1240 by 1240 pixels; wide-field fundus photograph from neonatal ROP screening; camera: Phoenix ICON (100° FOV).
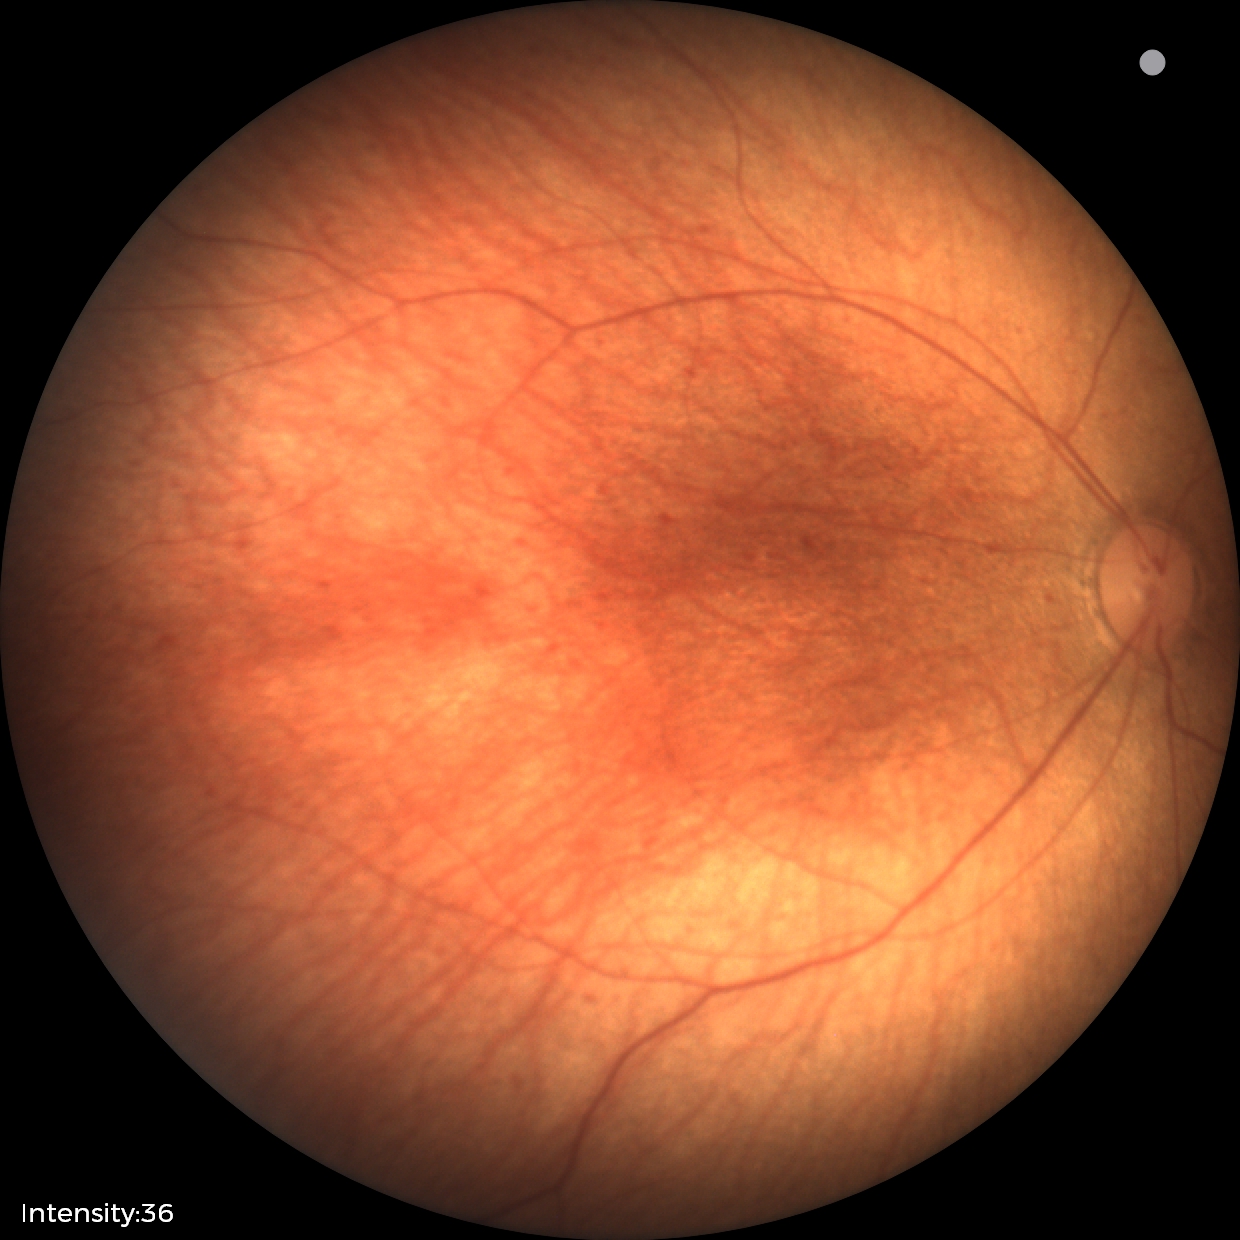 Impression: normal retinal appearance.